Image size 2352x1568 · 45° field of view — 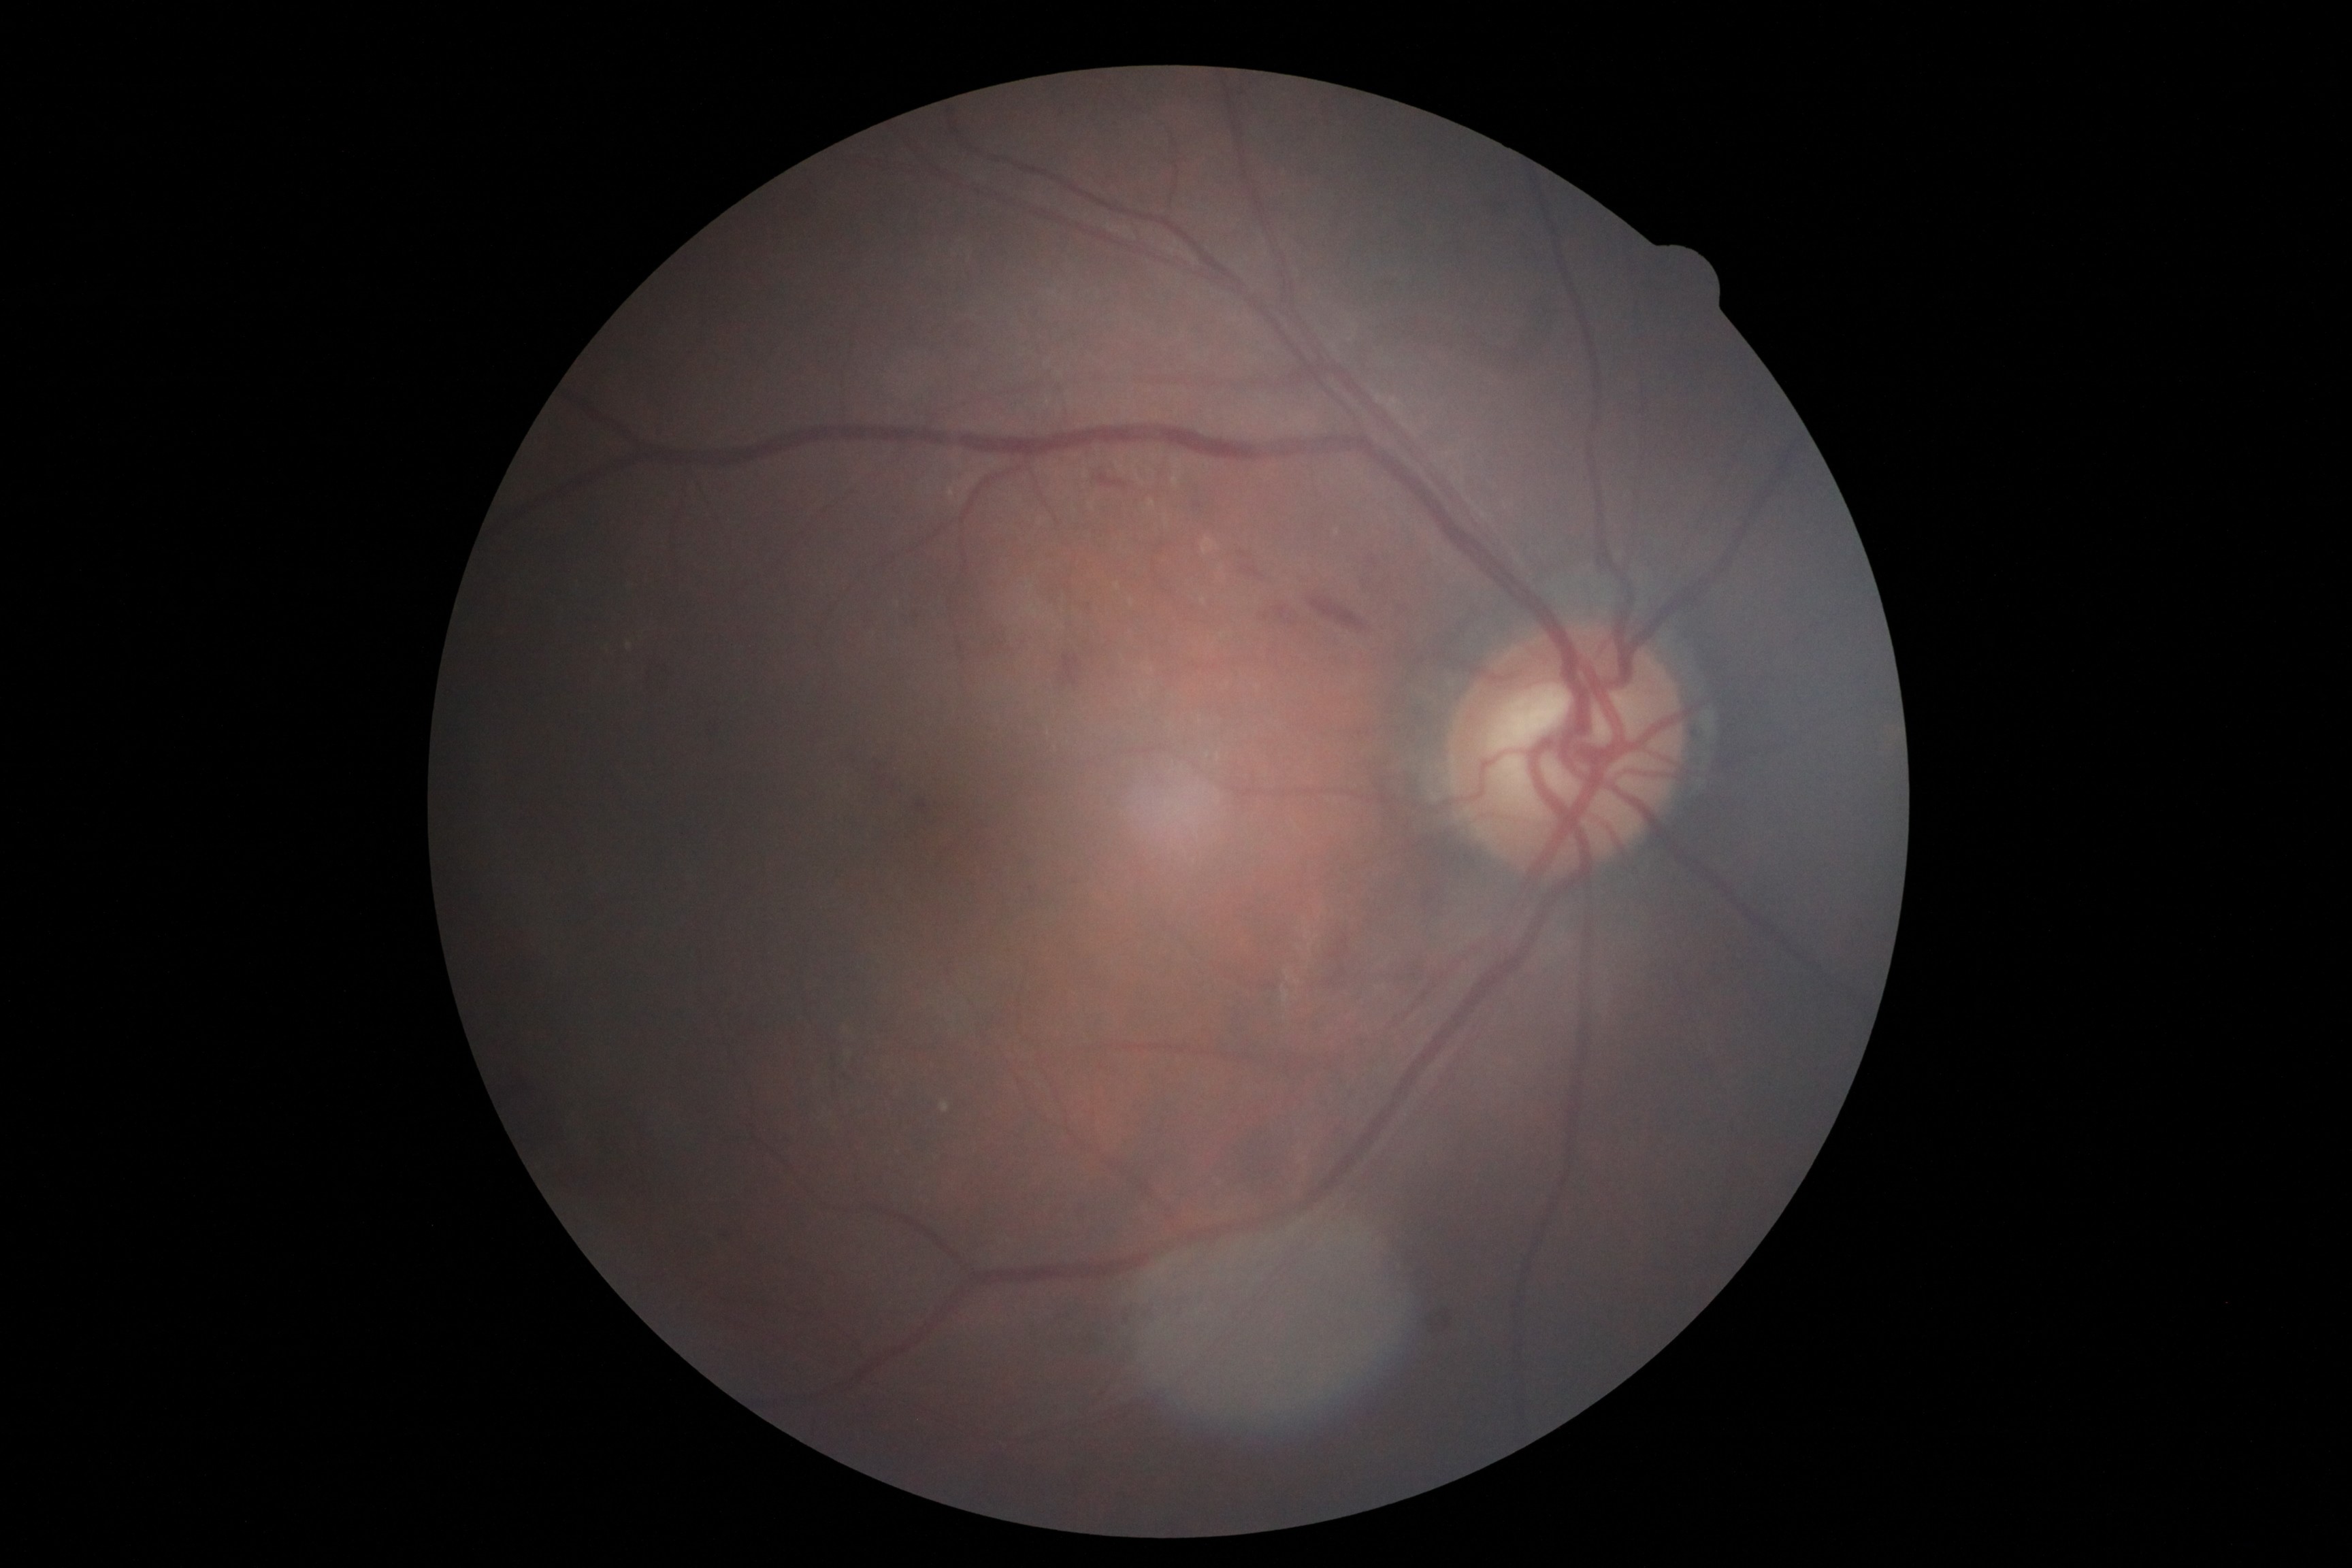
Diabetic retinopathy (DR) is grade 2 (moderate NPDR).